2048x1536px: 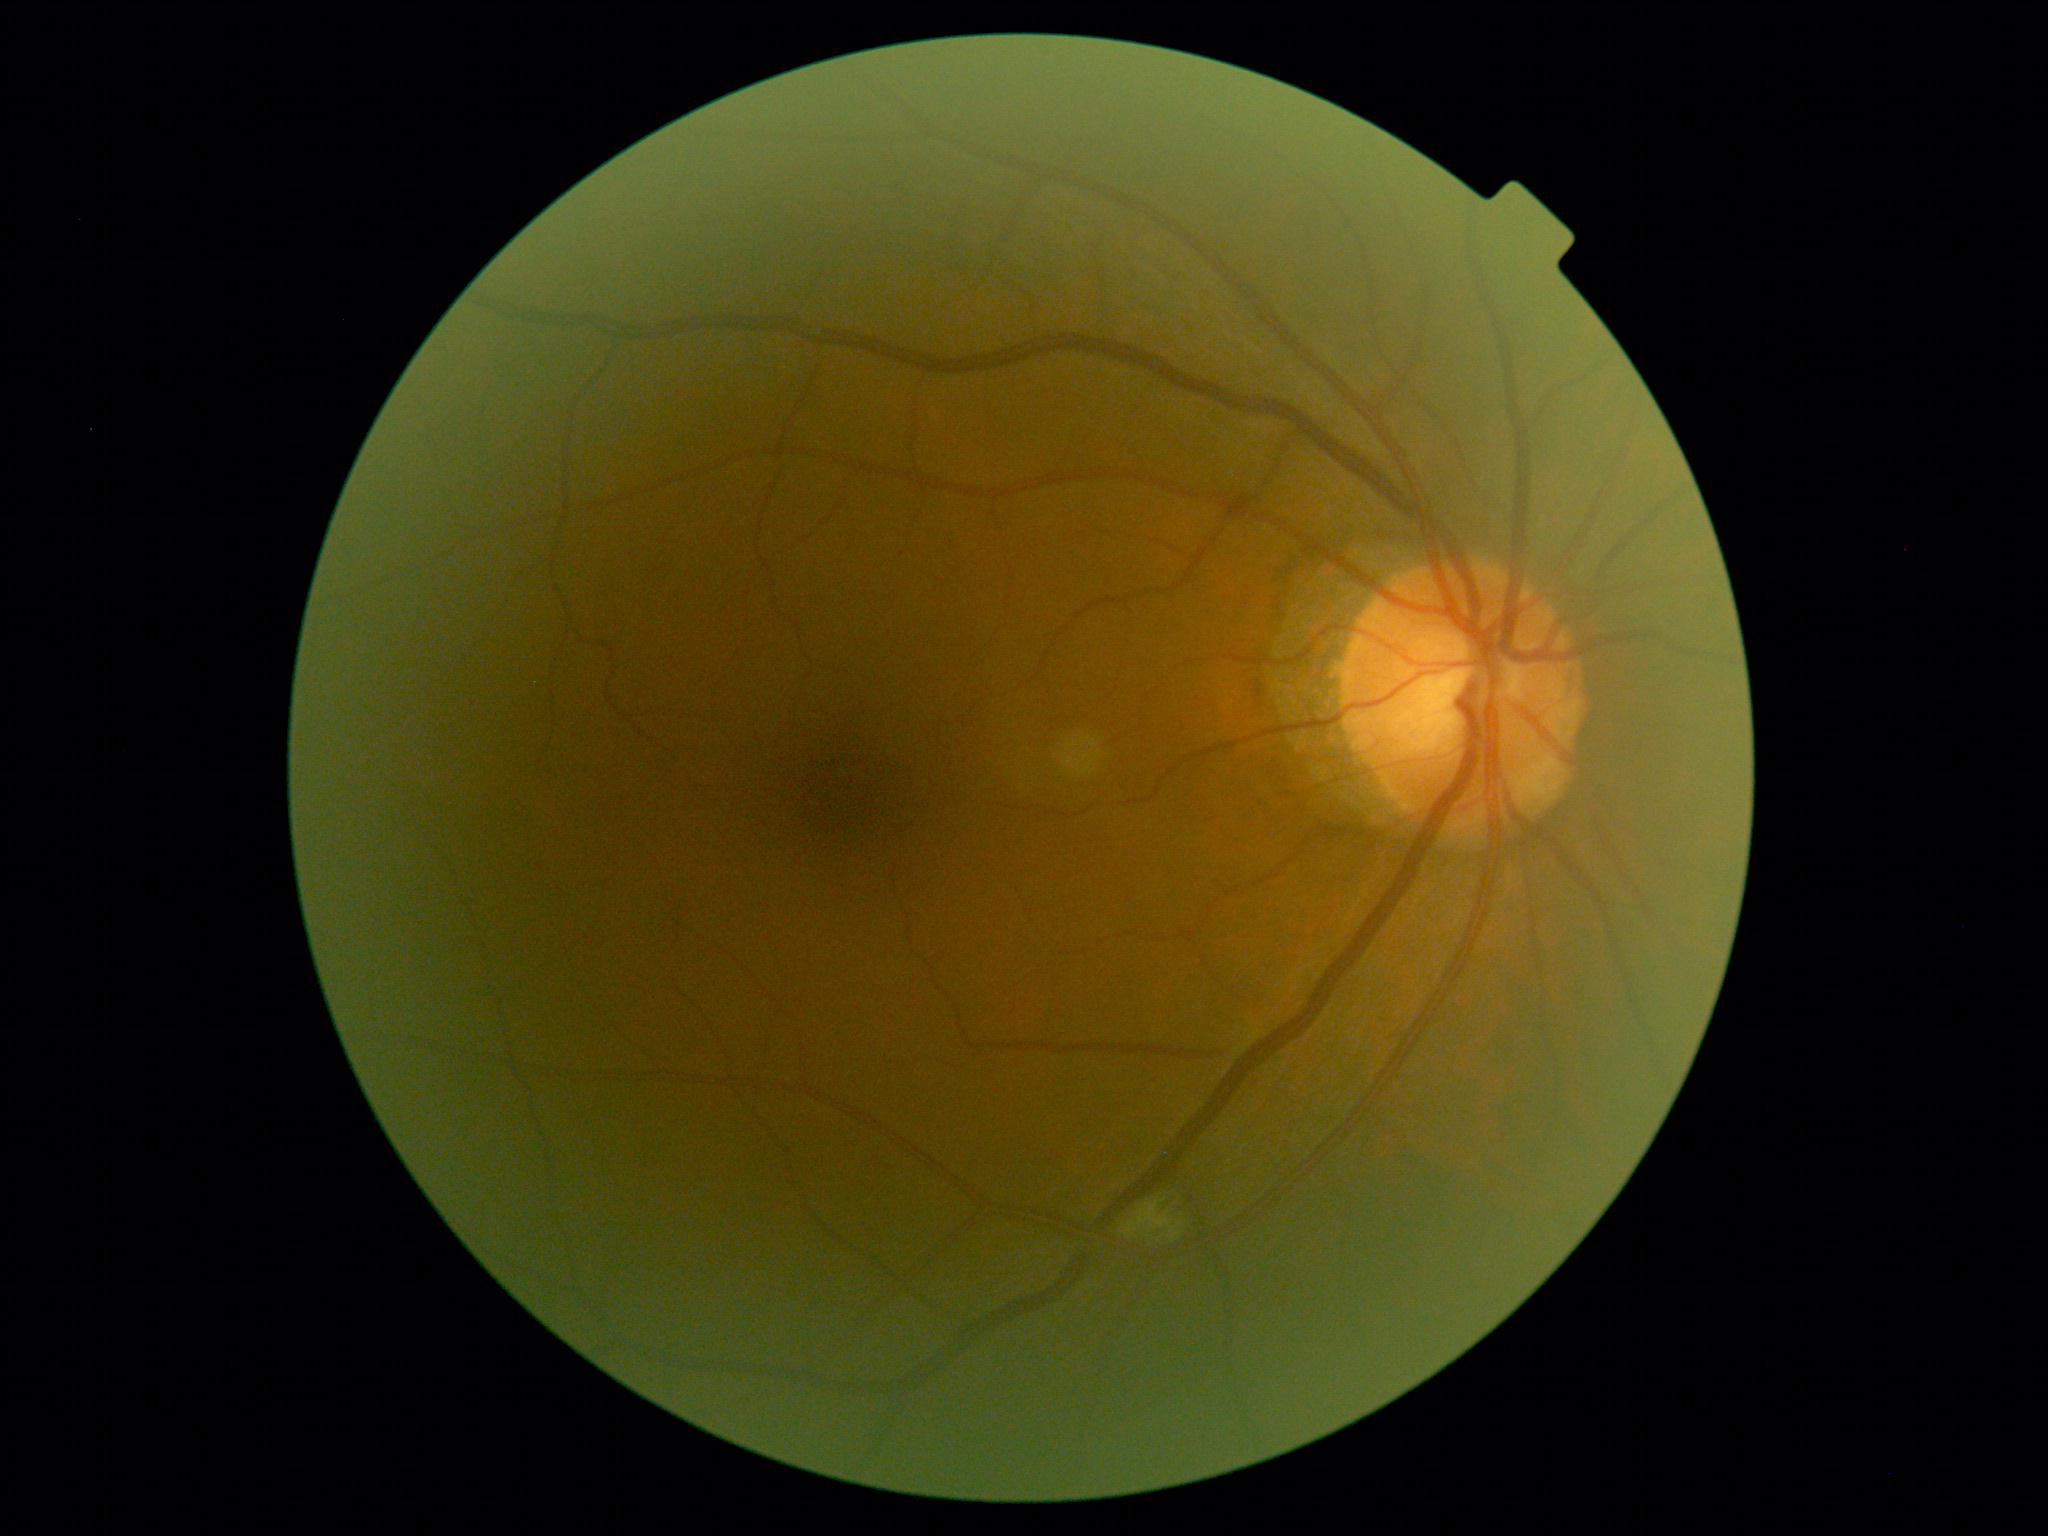 DR severity: moderate NPDR (grade 2).